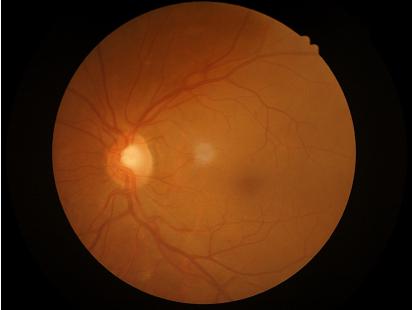

Overall = acceptable; Contrast = adequate; Illumination = even.